NIDEK AFC-230 fundus camera. CFP. 848 by 848 pixels. No pharmacologic dilation
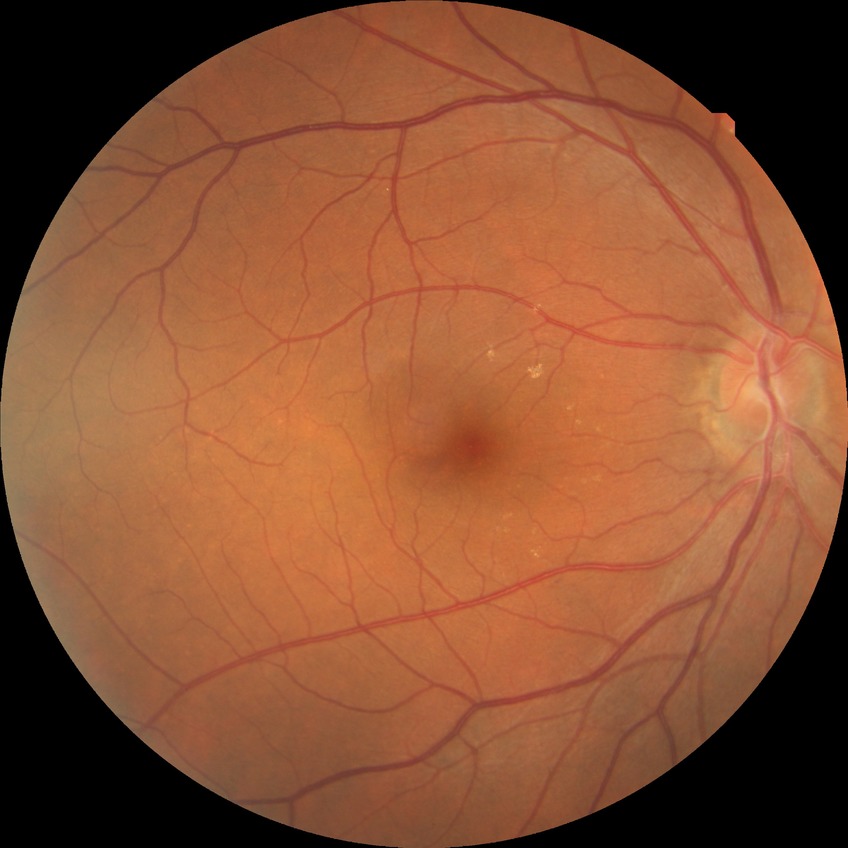 Diabetic retinopathy grade: no diabetic retinopathy.